Modified Davis grading.
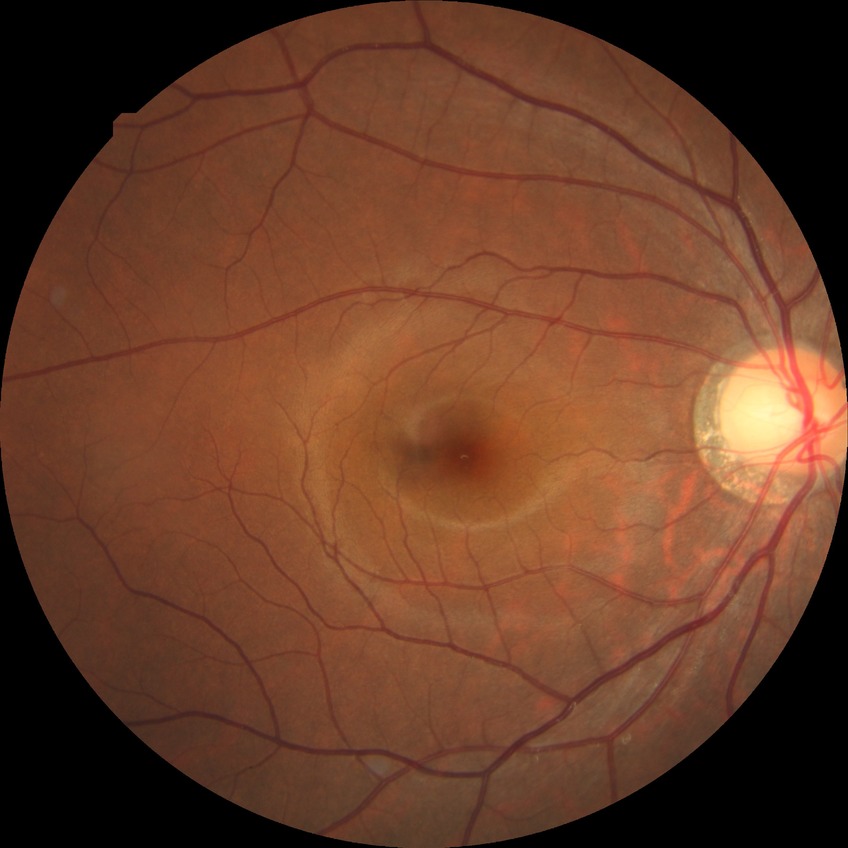

Diabetic retinopathy (DR) is NDR (no diabetic retinopathy).